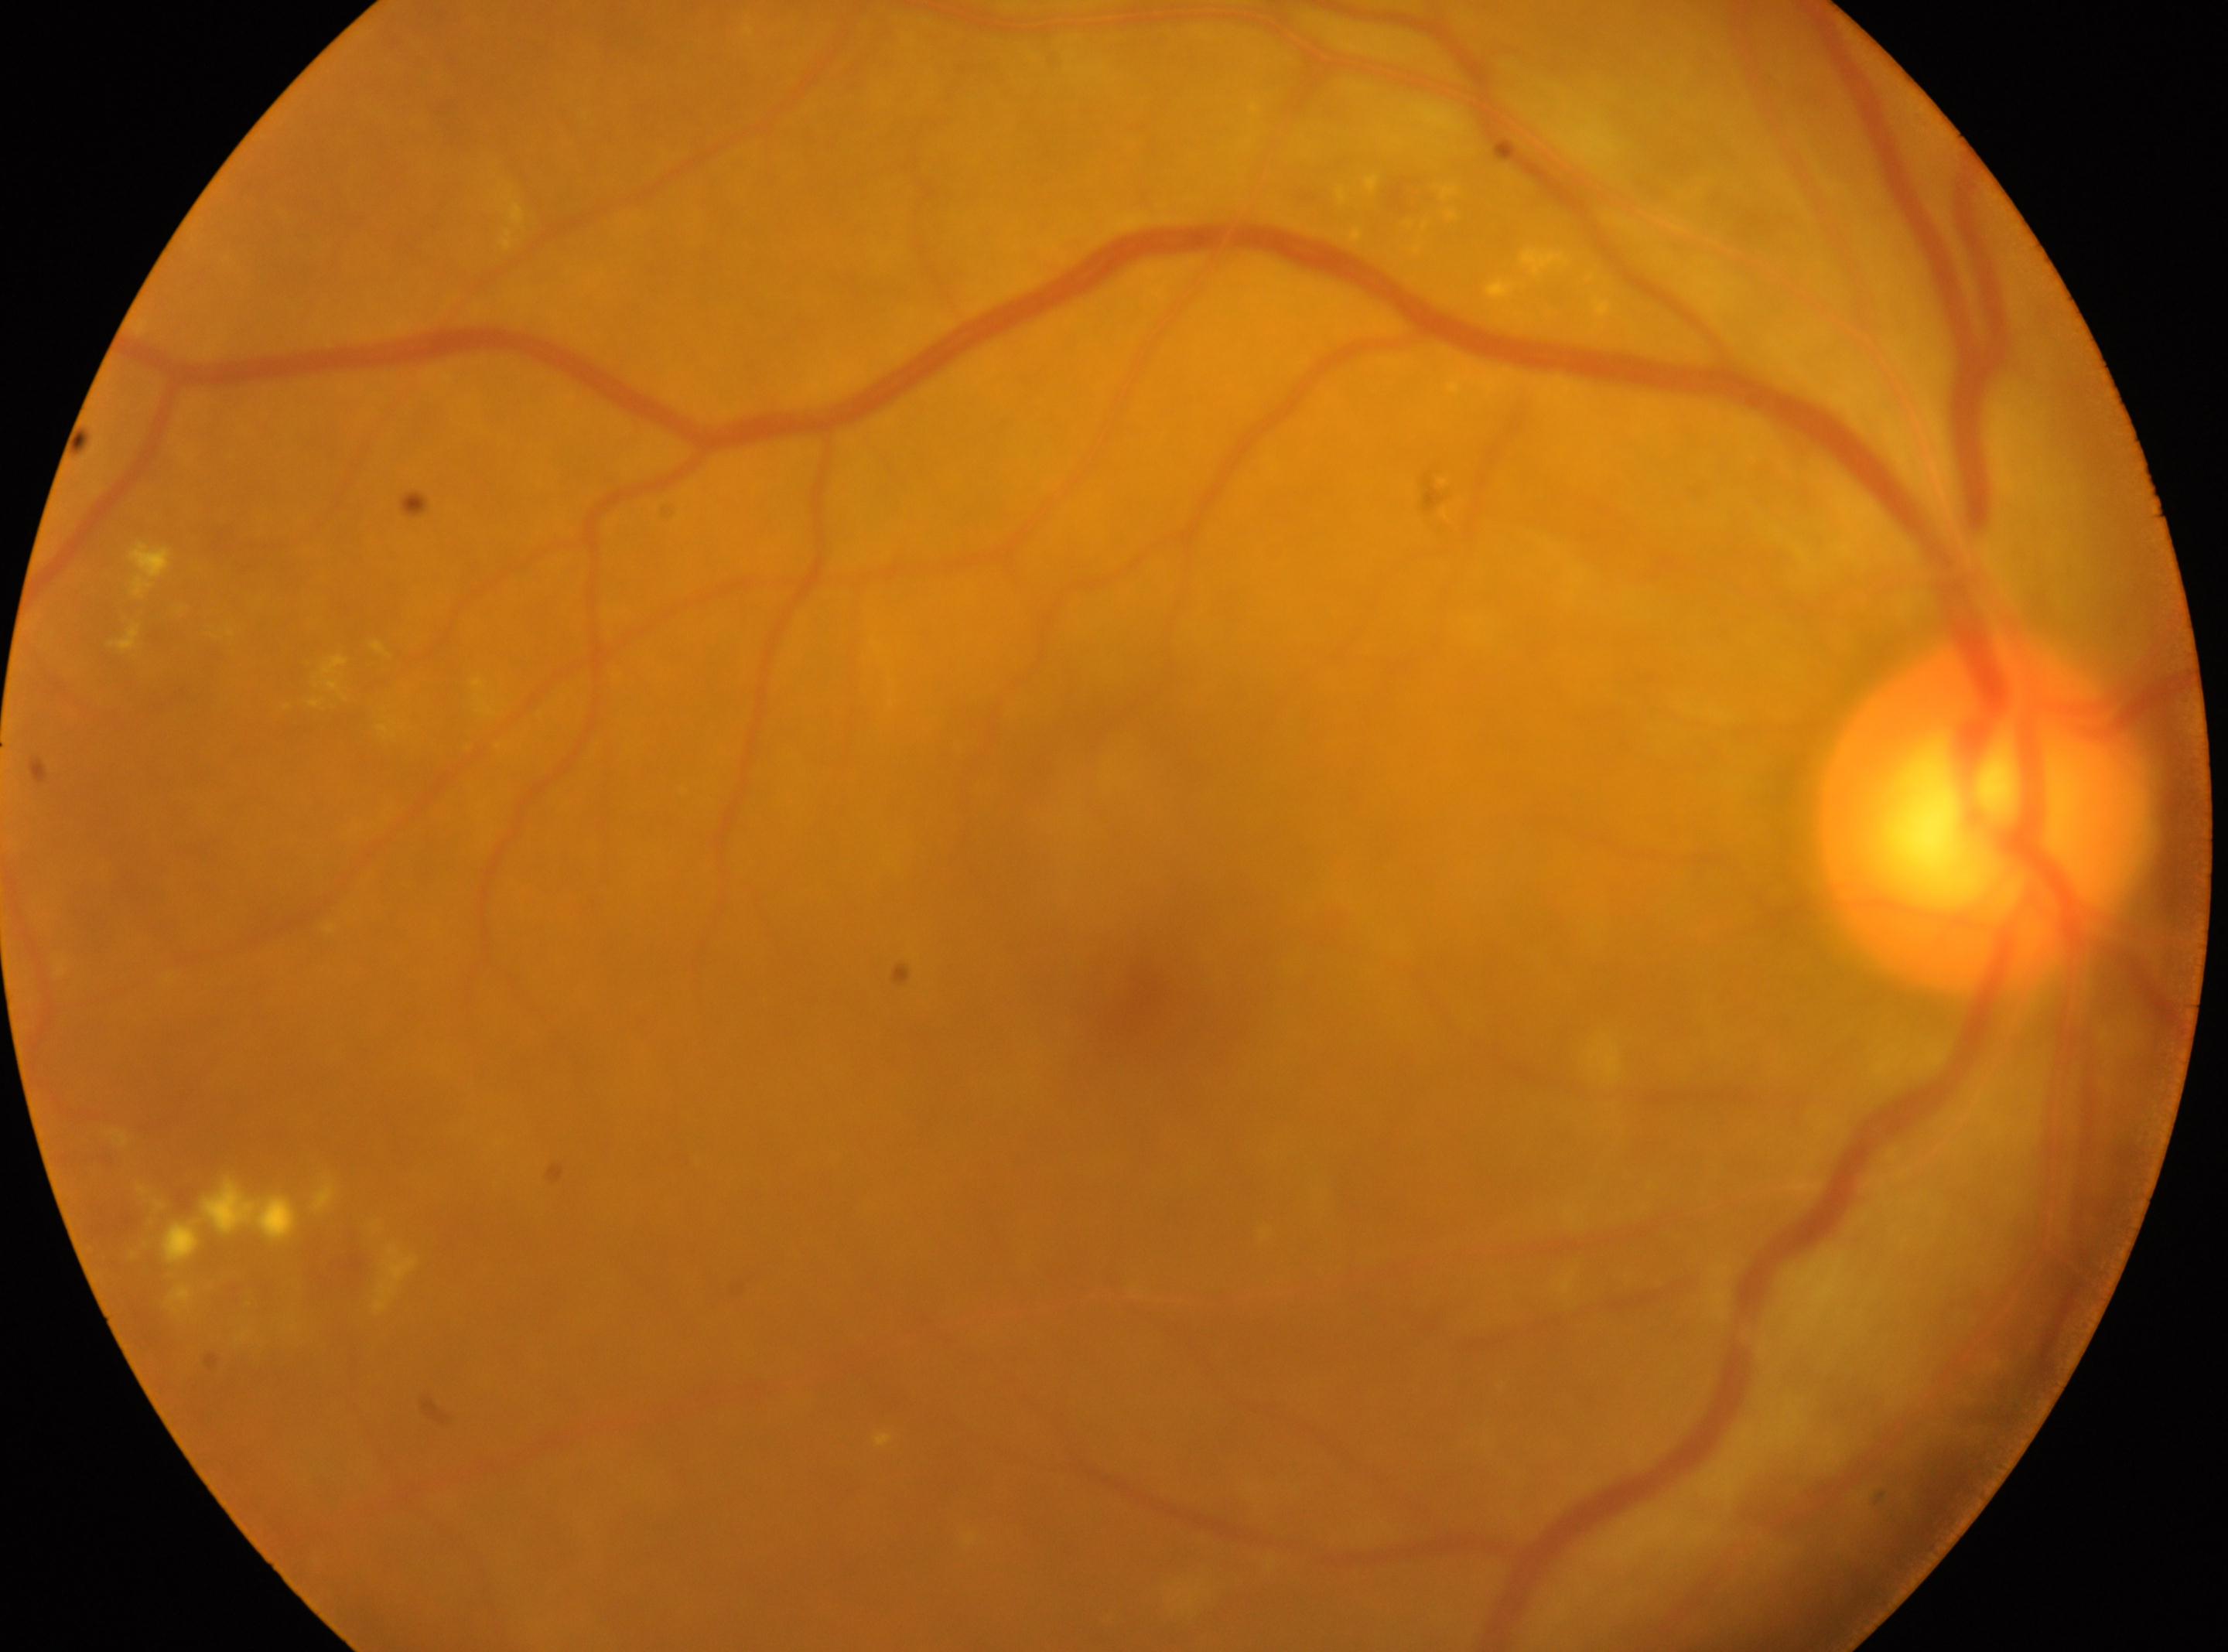

Imaged eye: OD. Fovea located at x=1150, y=988. Diabetic retinopathy (DR): 2. Optic disc: x=1984, y=820.